CFP
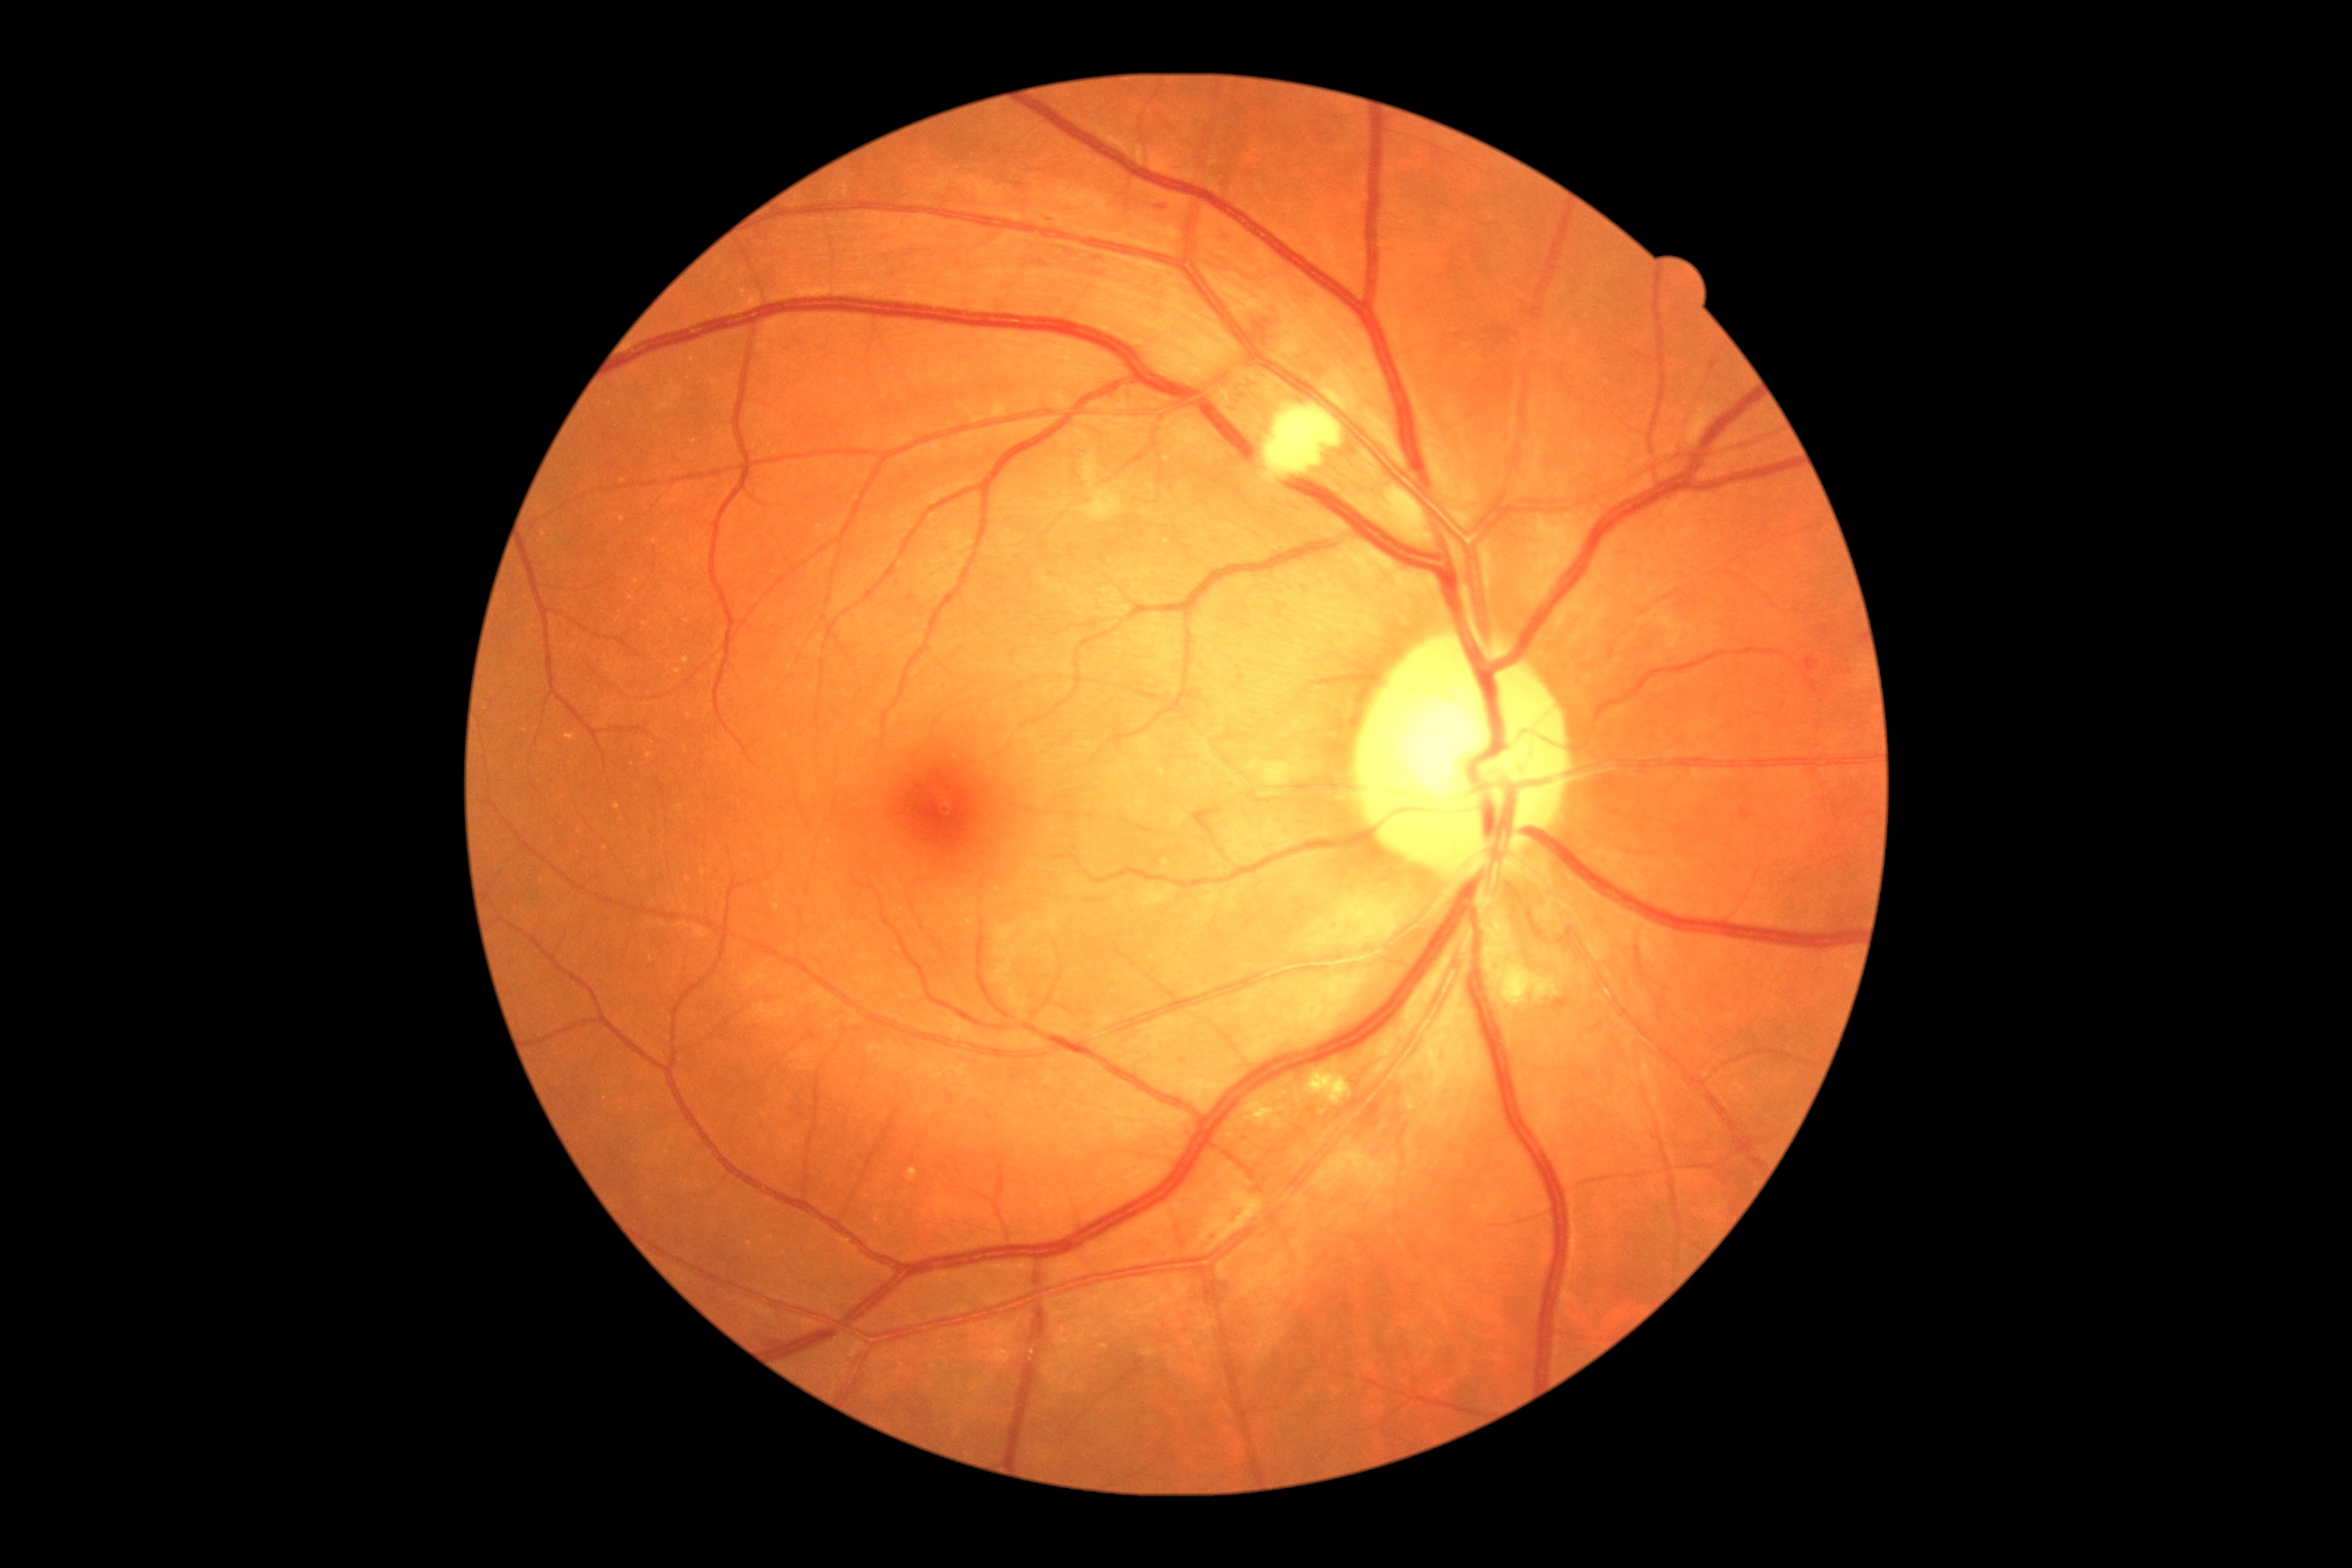
partial: true
dr_grade: 2
dr_grade_name: moderate NPDR
lesions:
  he:
    - <box>1250,308,1280,353</box>
    - <box>1803,658,1819,674</box>
  ex:
    - <box>1239,1095,1288,1130</box>
    - <box>1306,1068,1353,1106</box>
    - <box>906,1168,917,1182</box>
  ma:
    - <box>1014,184,1024,190</box>
    - <box>1741,808,1752,819</box>
    - <box>1222,239,1230,250</box>
    - <box>1845,667,1850,676</box>
    - <box>1553,997,1571,1010</box>
    - <box>1044,217,1054,224</box>
    - <box>906,596,916,602</box>
    - <box>1244,380,1253,386</box>
  ma_small_approx:
    - (1232; 787)
    - (1232; 409)
    - (1238; 395)
  se:
    - <box>1073,451,1124,522</box>
    - <box>1264,404,1344,482</box>
    - <box>1380,485,1433,544</box>
    - <box>1485,941,1560,1006</box>